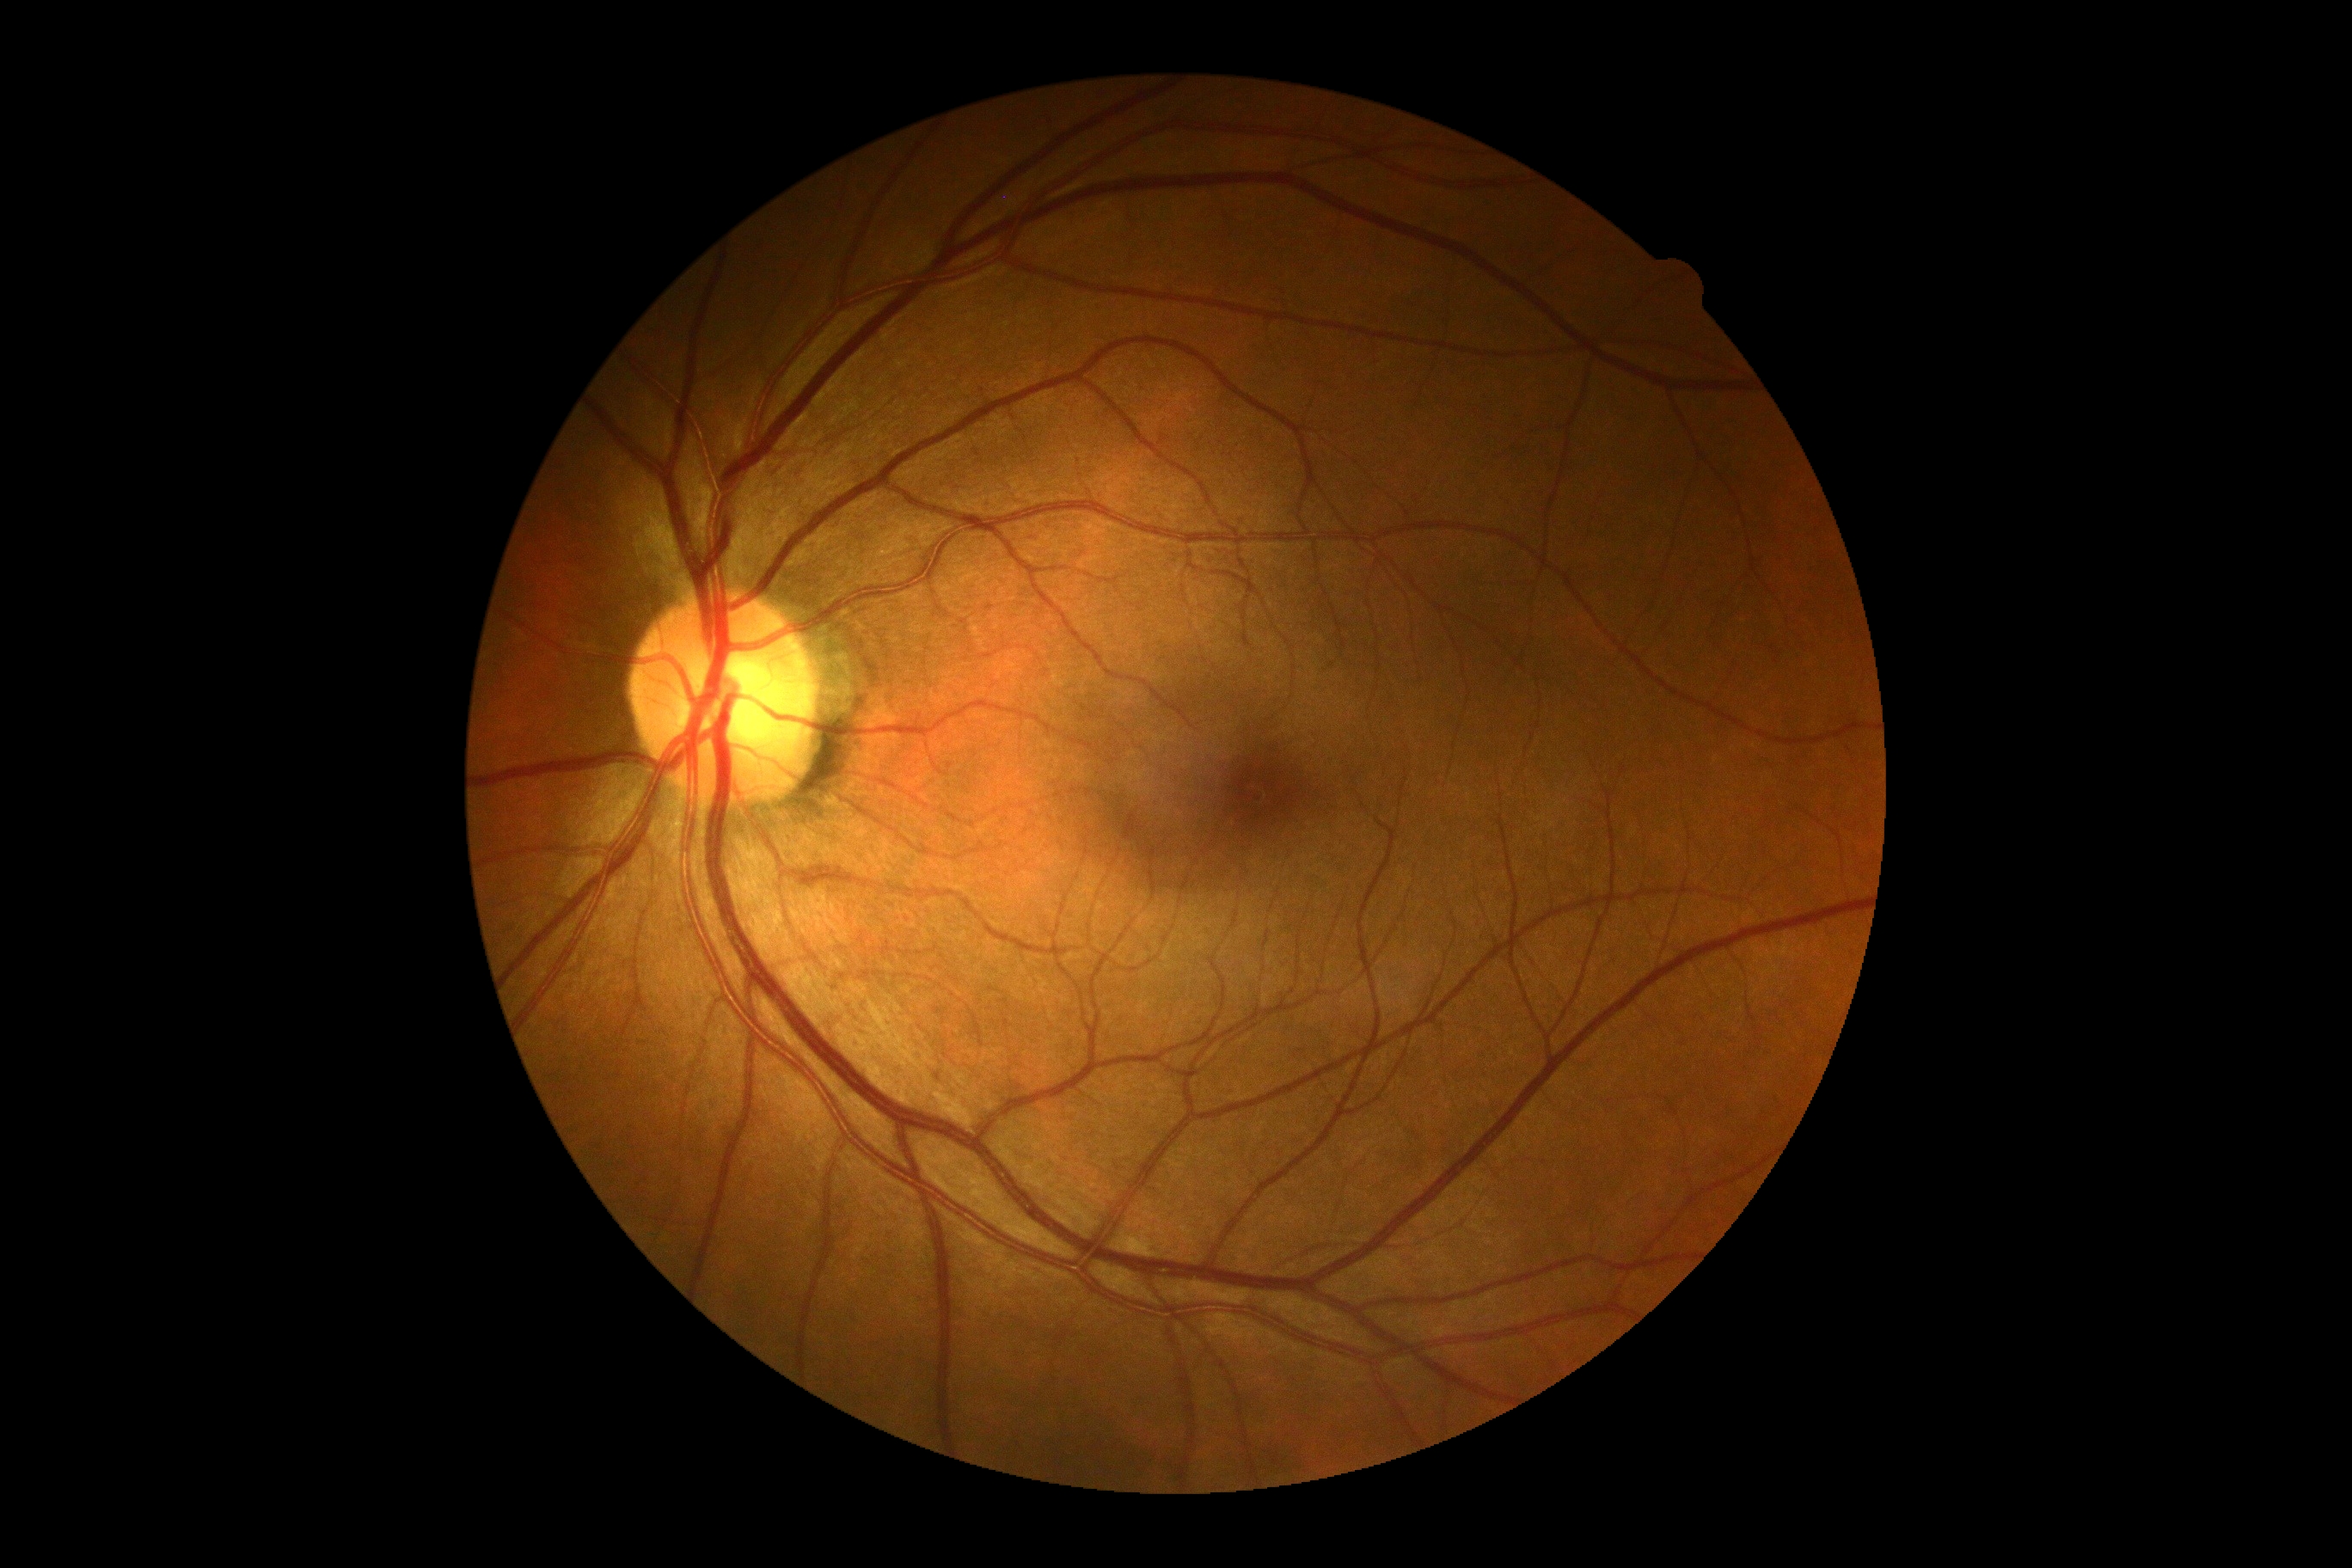
DR stage: grade 0 (no apparent retinopathy).